Pediatric wide-field fundus photograph. Image size 640x480. Acquired on the Clarity RetCam 3: 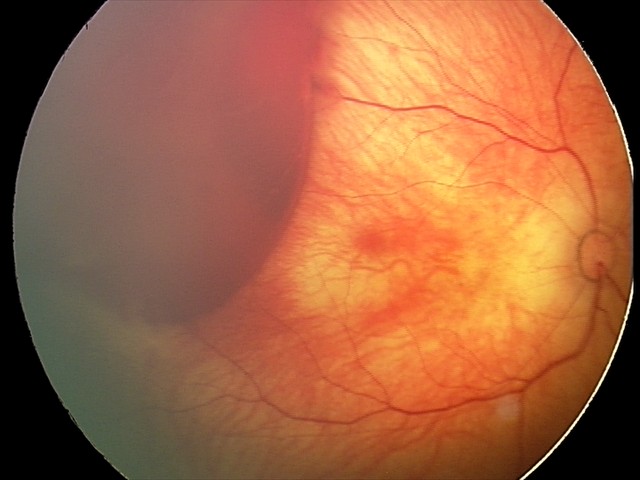

Assessment: retinal hemorrhages.